848x848.
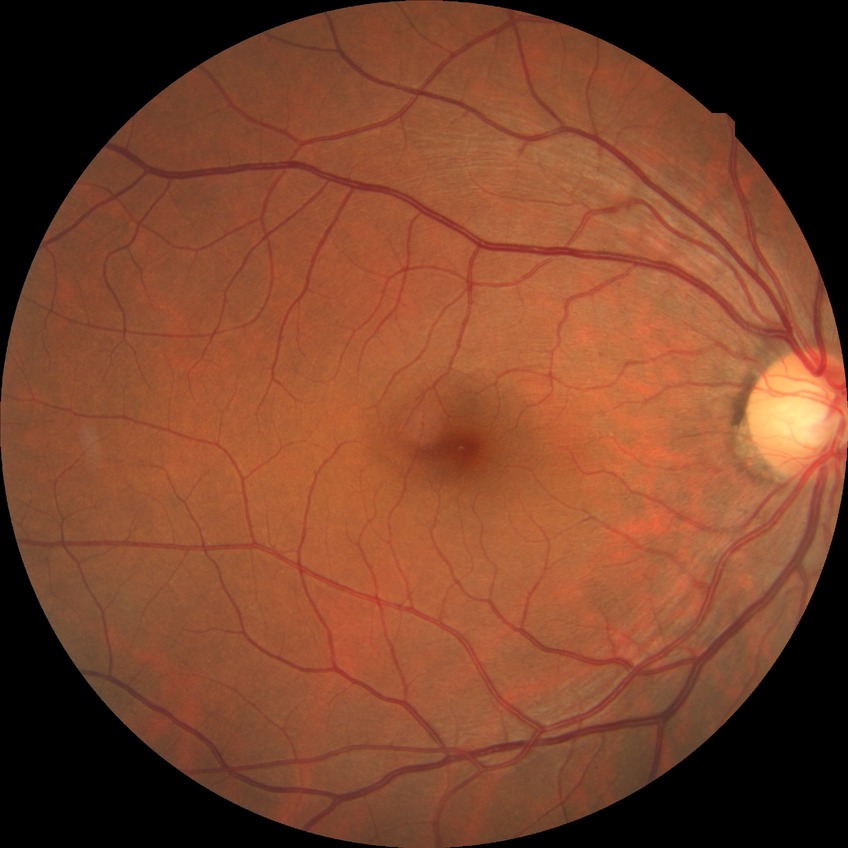 • diabetic retinopathy (DR): no diabetic retinopathy (NDR)